45-degree field of view:
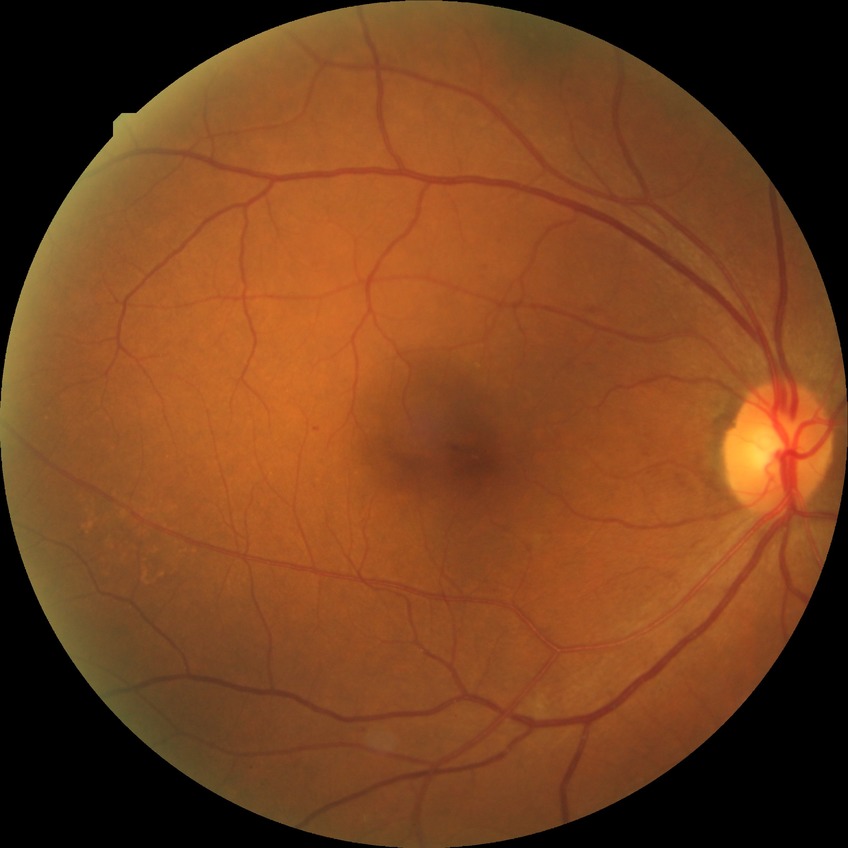
diabetic retinopathy (DR): pre-proliferative diabetic retinopathy (PPDR).